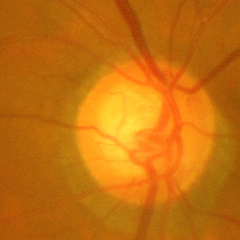 Glaucomatous optic neuropathy is present. Diagnosis = advanced glaucoma.